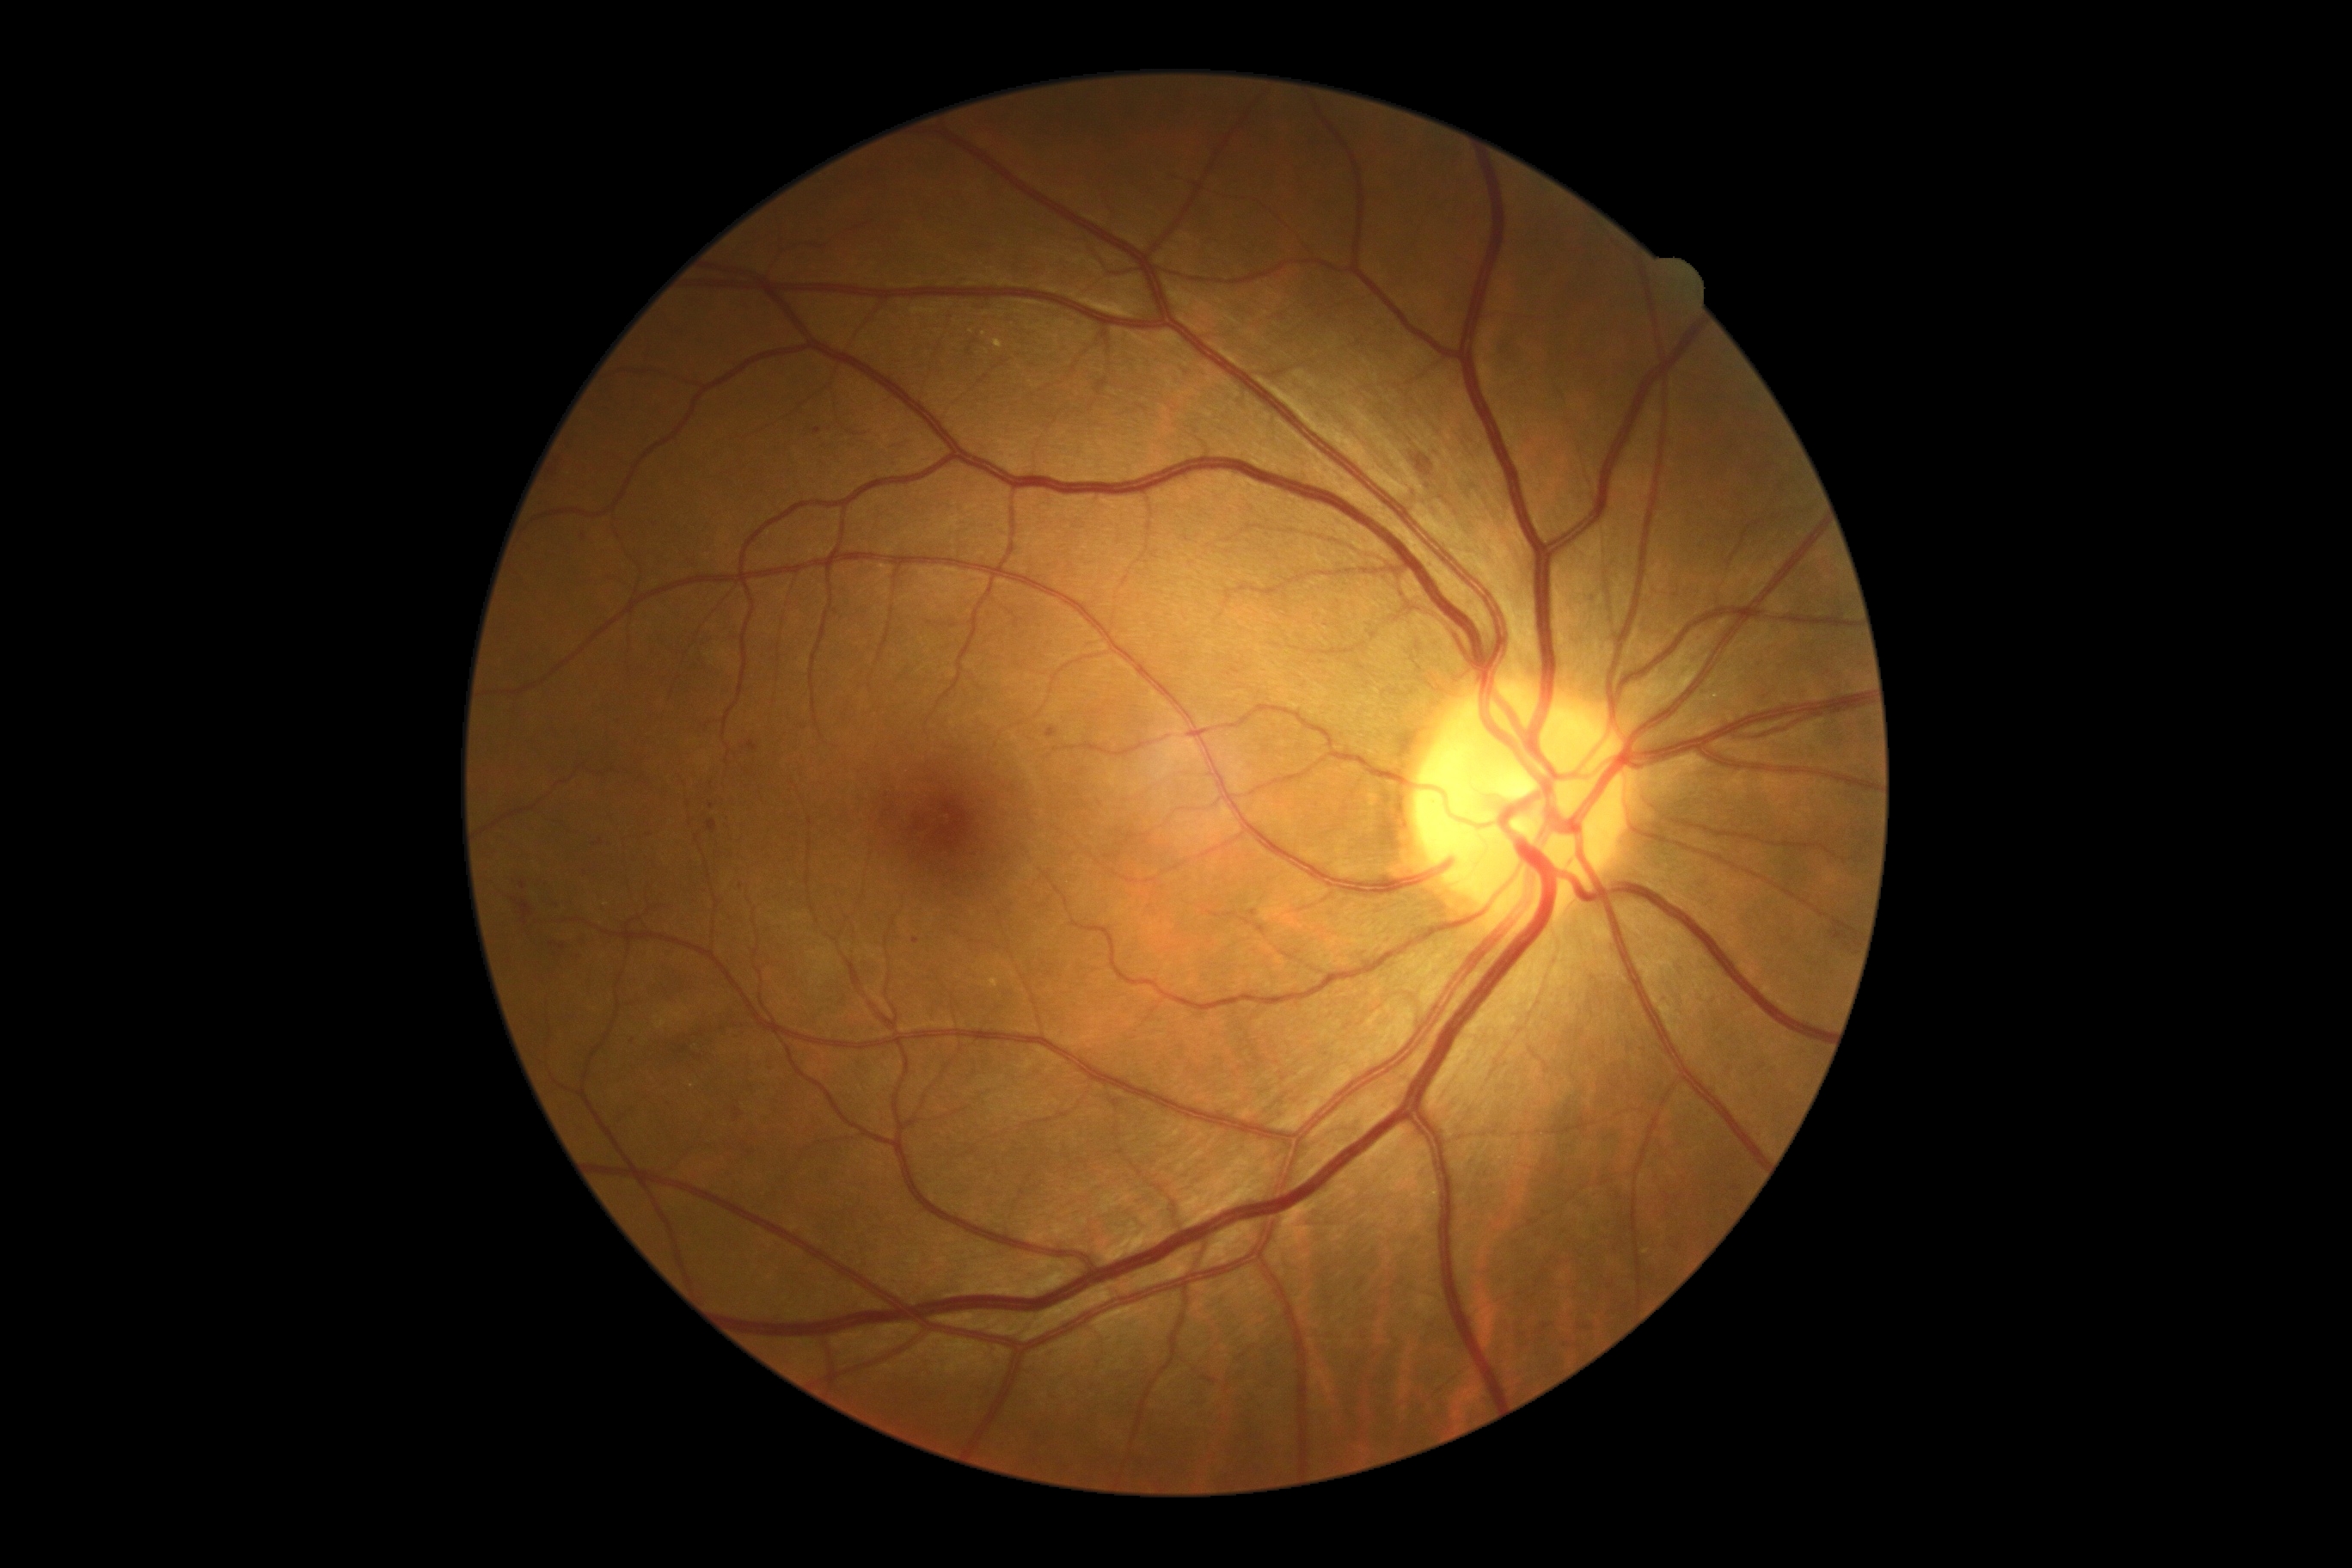

Retinopathy: moderate non-proliferative diabetic retinopathy (grade 2).